Clarity RetCam 3, 130° FOV · wide-field fundus photograph of an infant — 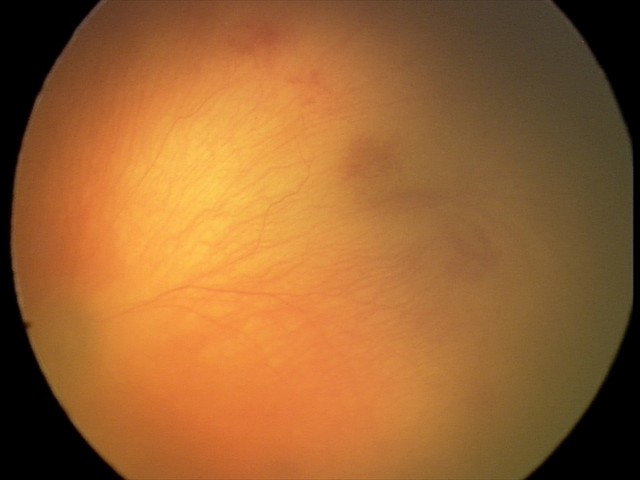
Screening: aggressive ROP (A-ROP) | plus disease.